1932 x 1910 pixels — 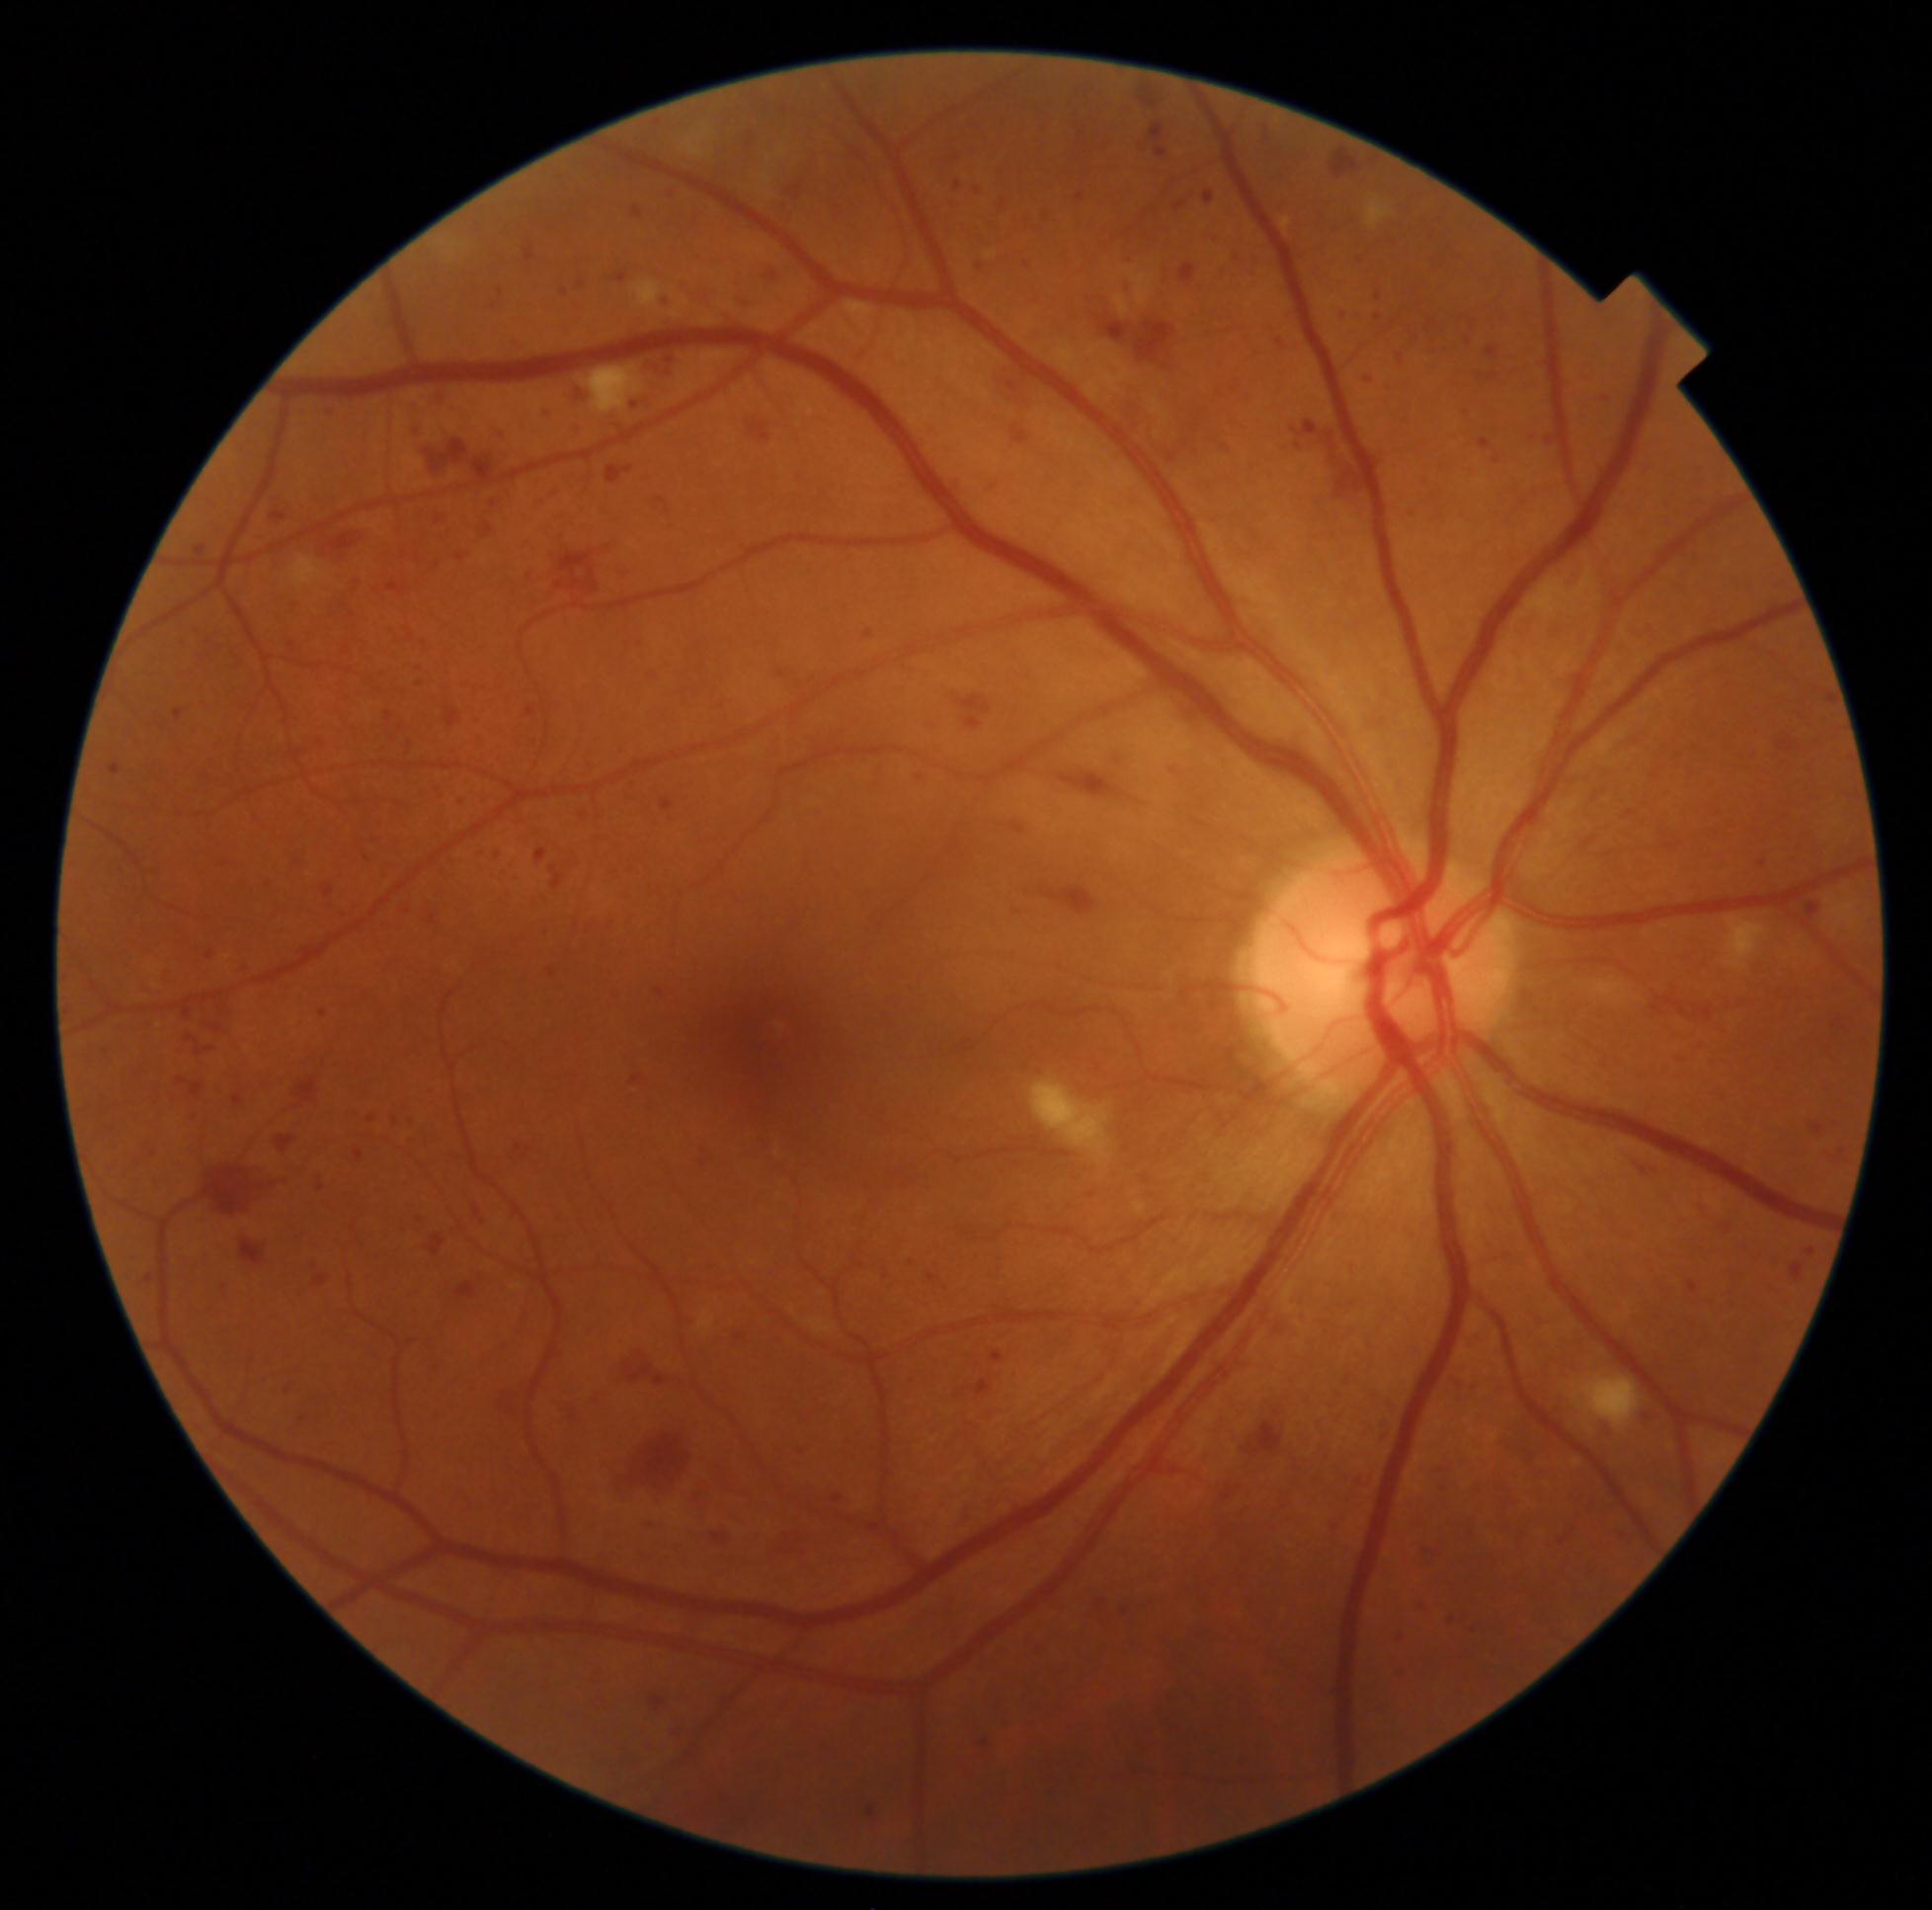 Diabetic retinopathy (DR): grade 3
Selected lesions:
hemorrhages (HEs) (more not shown): [1355, 312, 1366, 321], [1643, 1405, 1664, 1425], [1762, 1281, 1786, 1297], [1784, 1259, 1812, 1290], [336, 914, 350, 923], [1041, 886, 1096, 916], [747, 423, 771, 443], [1262, 323, 1280, 333], [614, 744, 628, 757], [1580, 365, 1596, 385], [343, 576, 361, 592], [1214, 388, 1229, 403], [982, 474, 1006, 500], [526, 542, 619, 594], [666, 185, 684, 203], [1832, 1118, 1846, 1129], [294, 406, 311, 421], [955, 182, 962, 191]
HEs (small, approximate centers) near pt(585, 816), pt(980, 266)